45° FOV, color fundus image, 1380 x 1382 pixels.
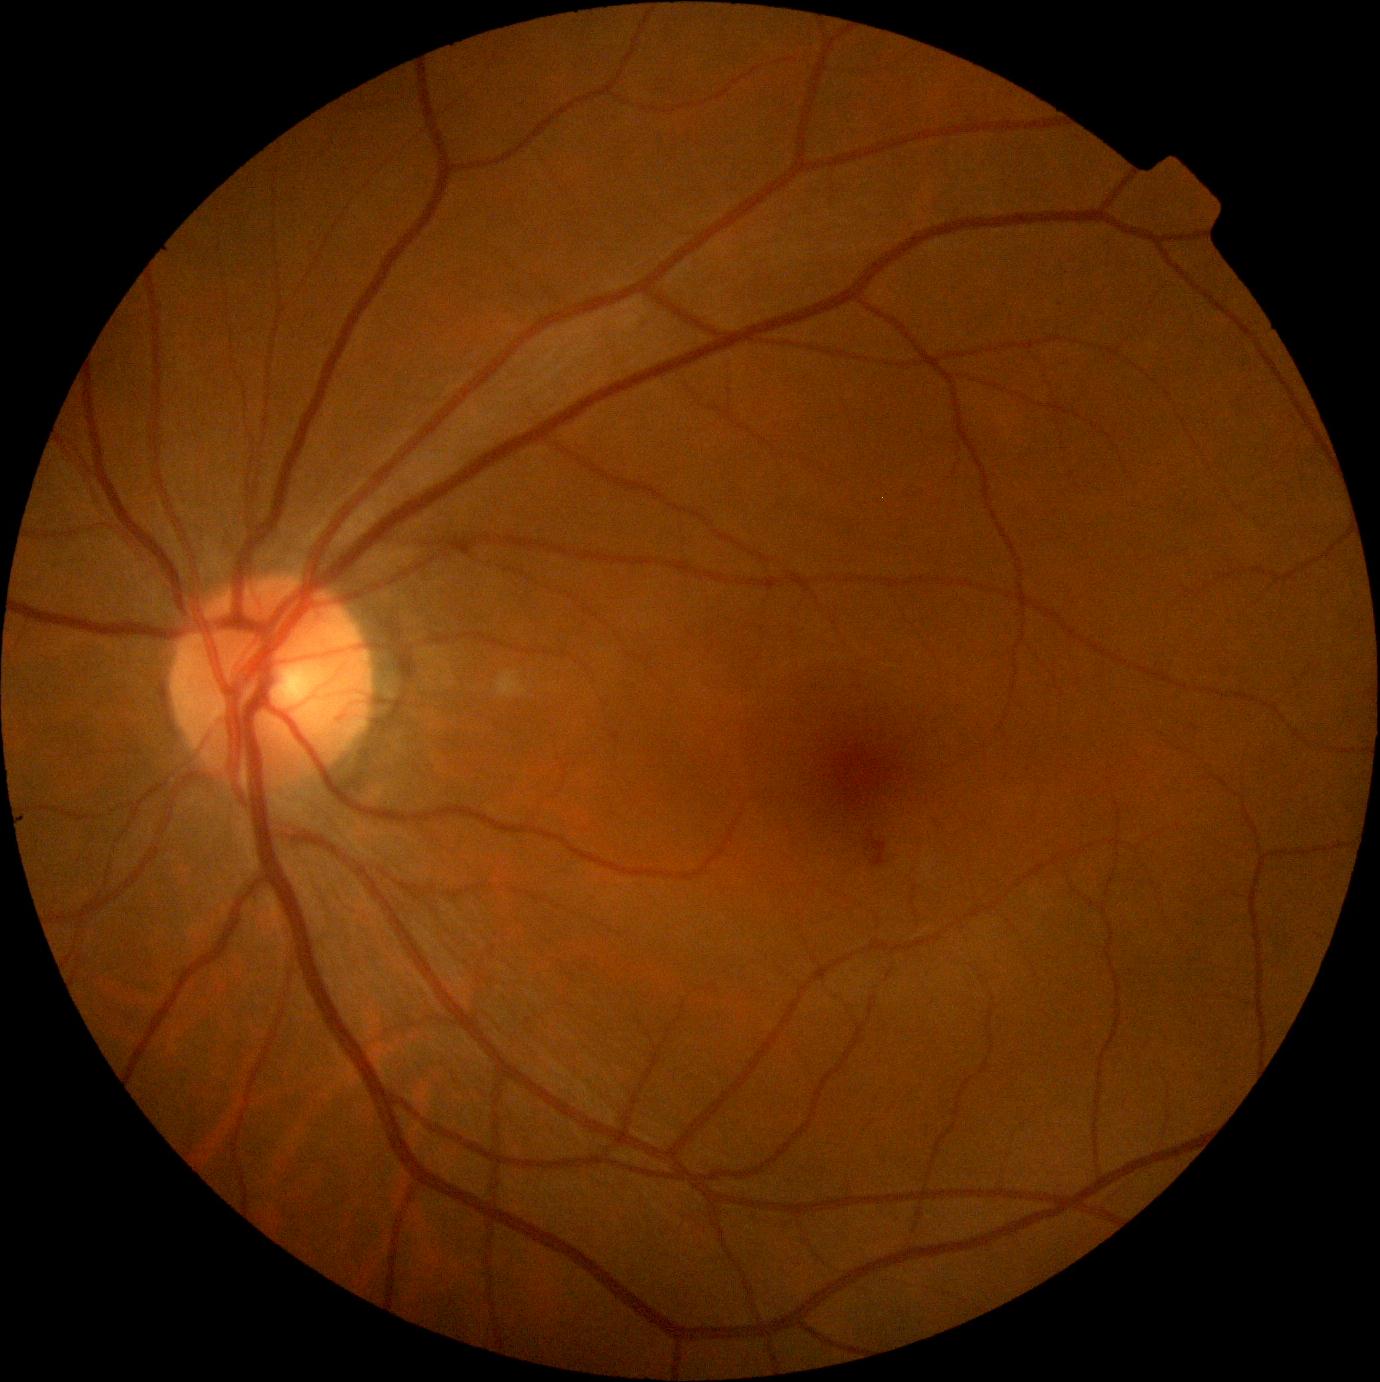

DR stage: grade 2.